Ultra-widefield (UWF) fundus image:
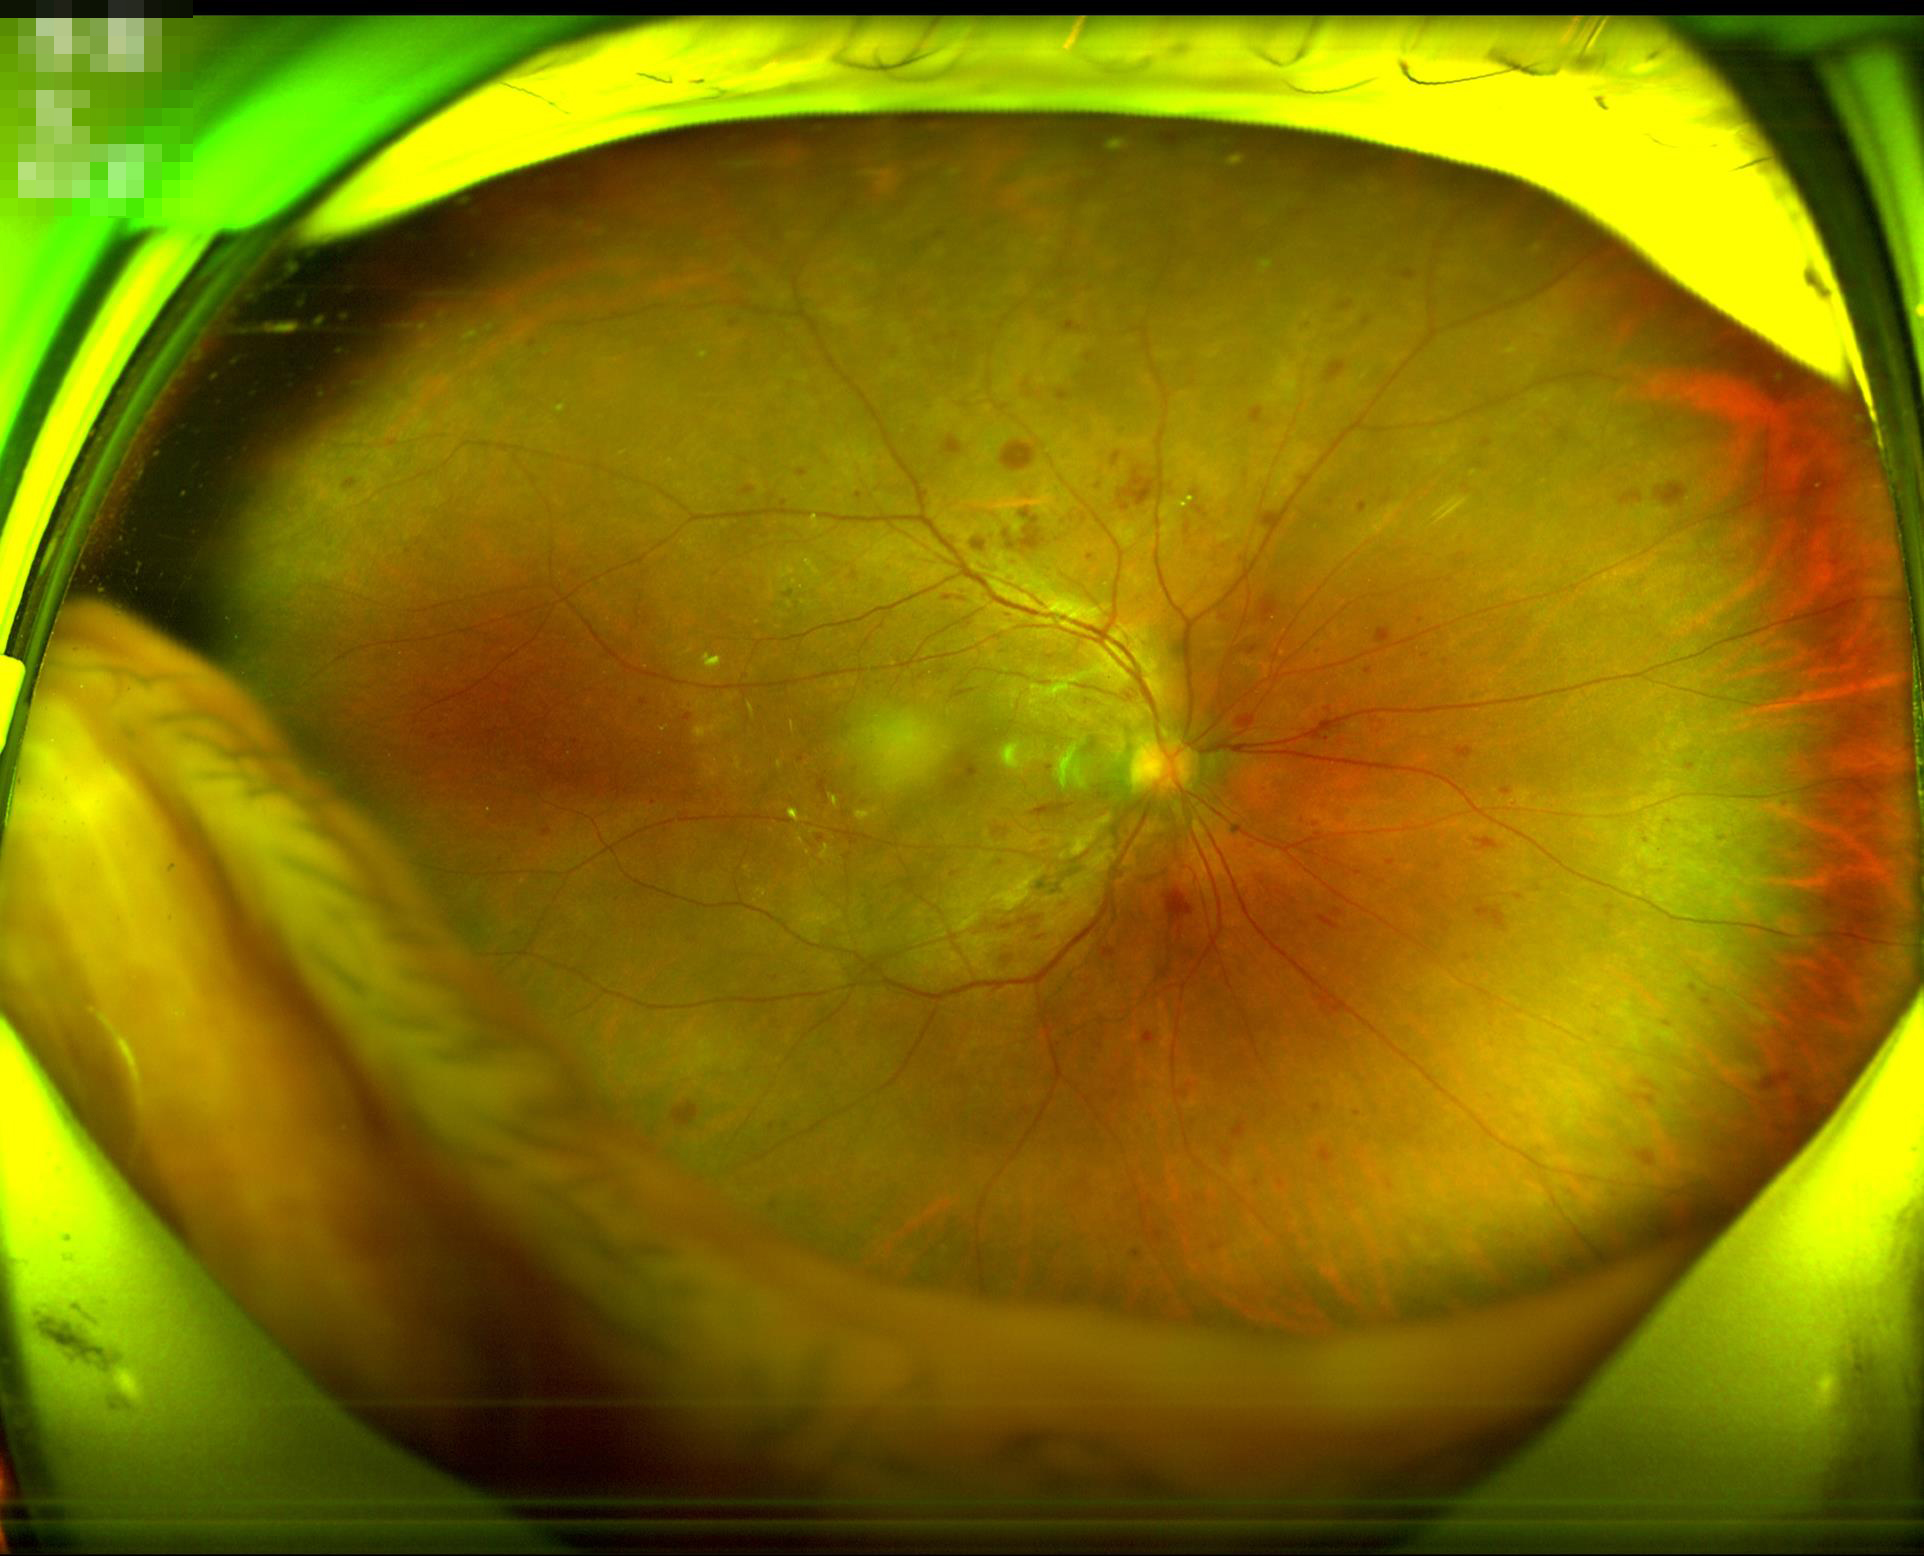

Contrast is good.
Overall image quality is good.
The image is clear.